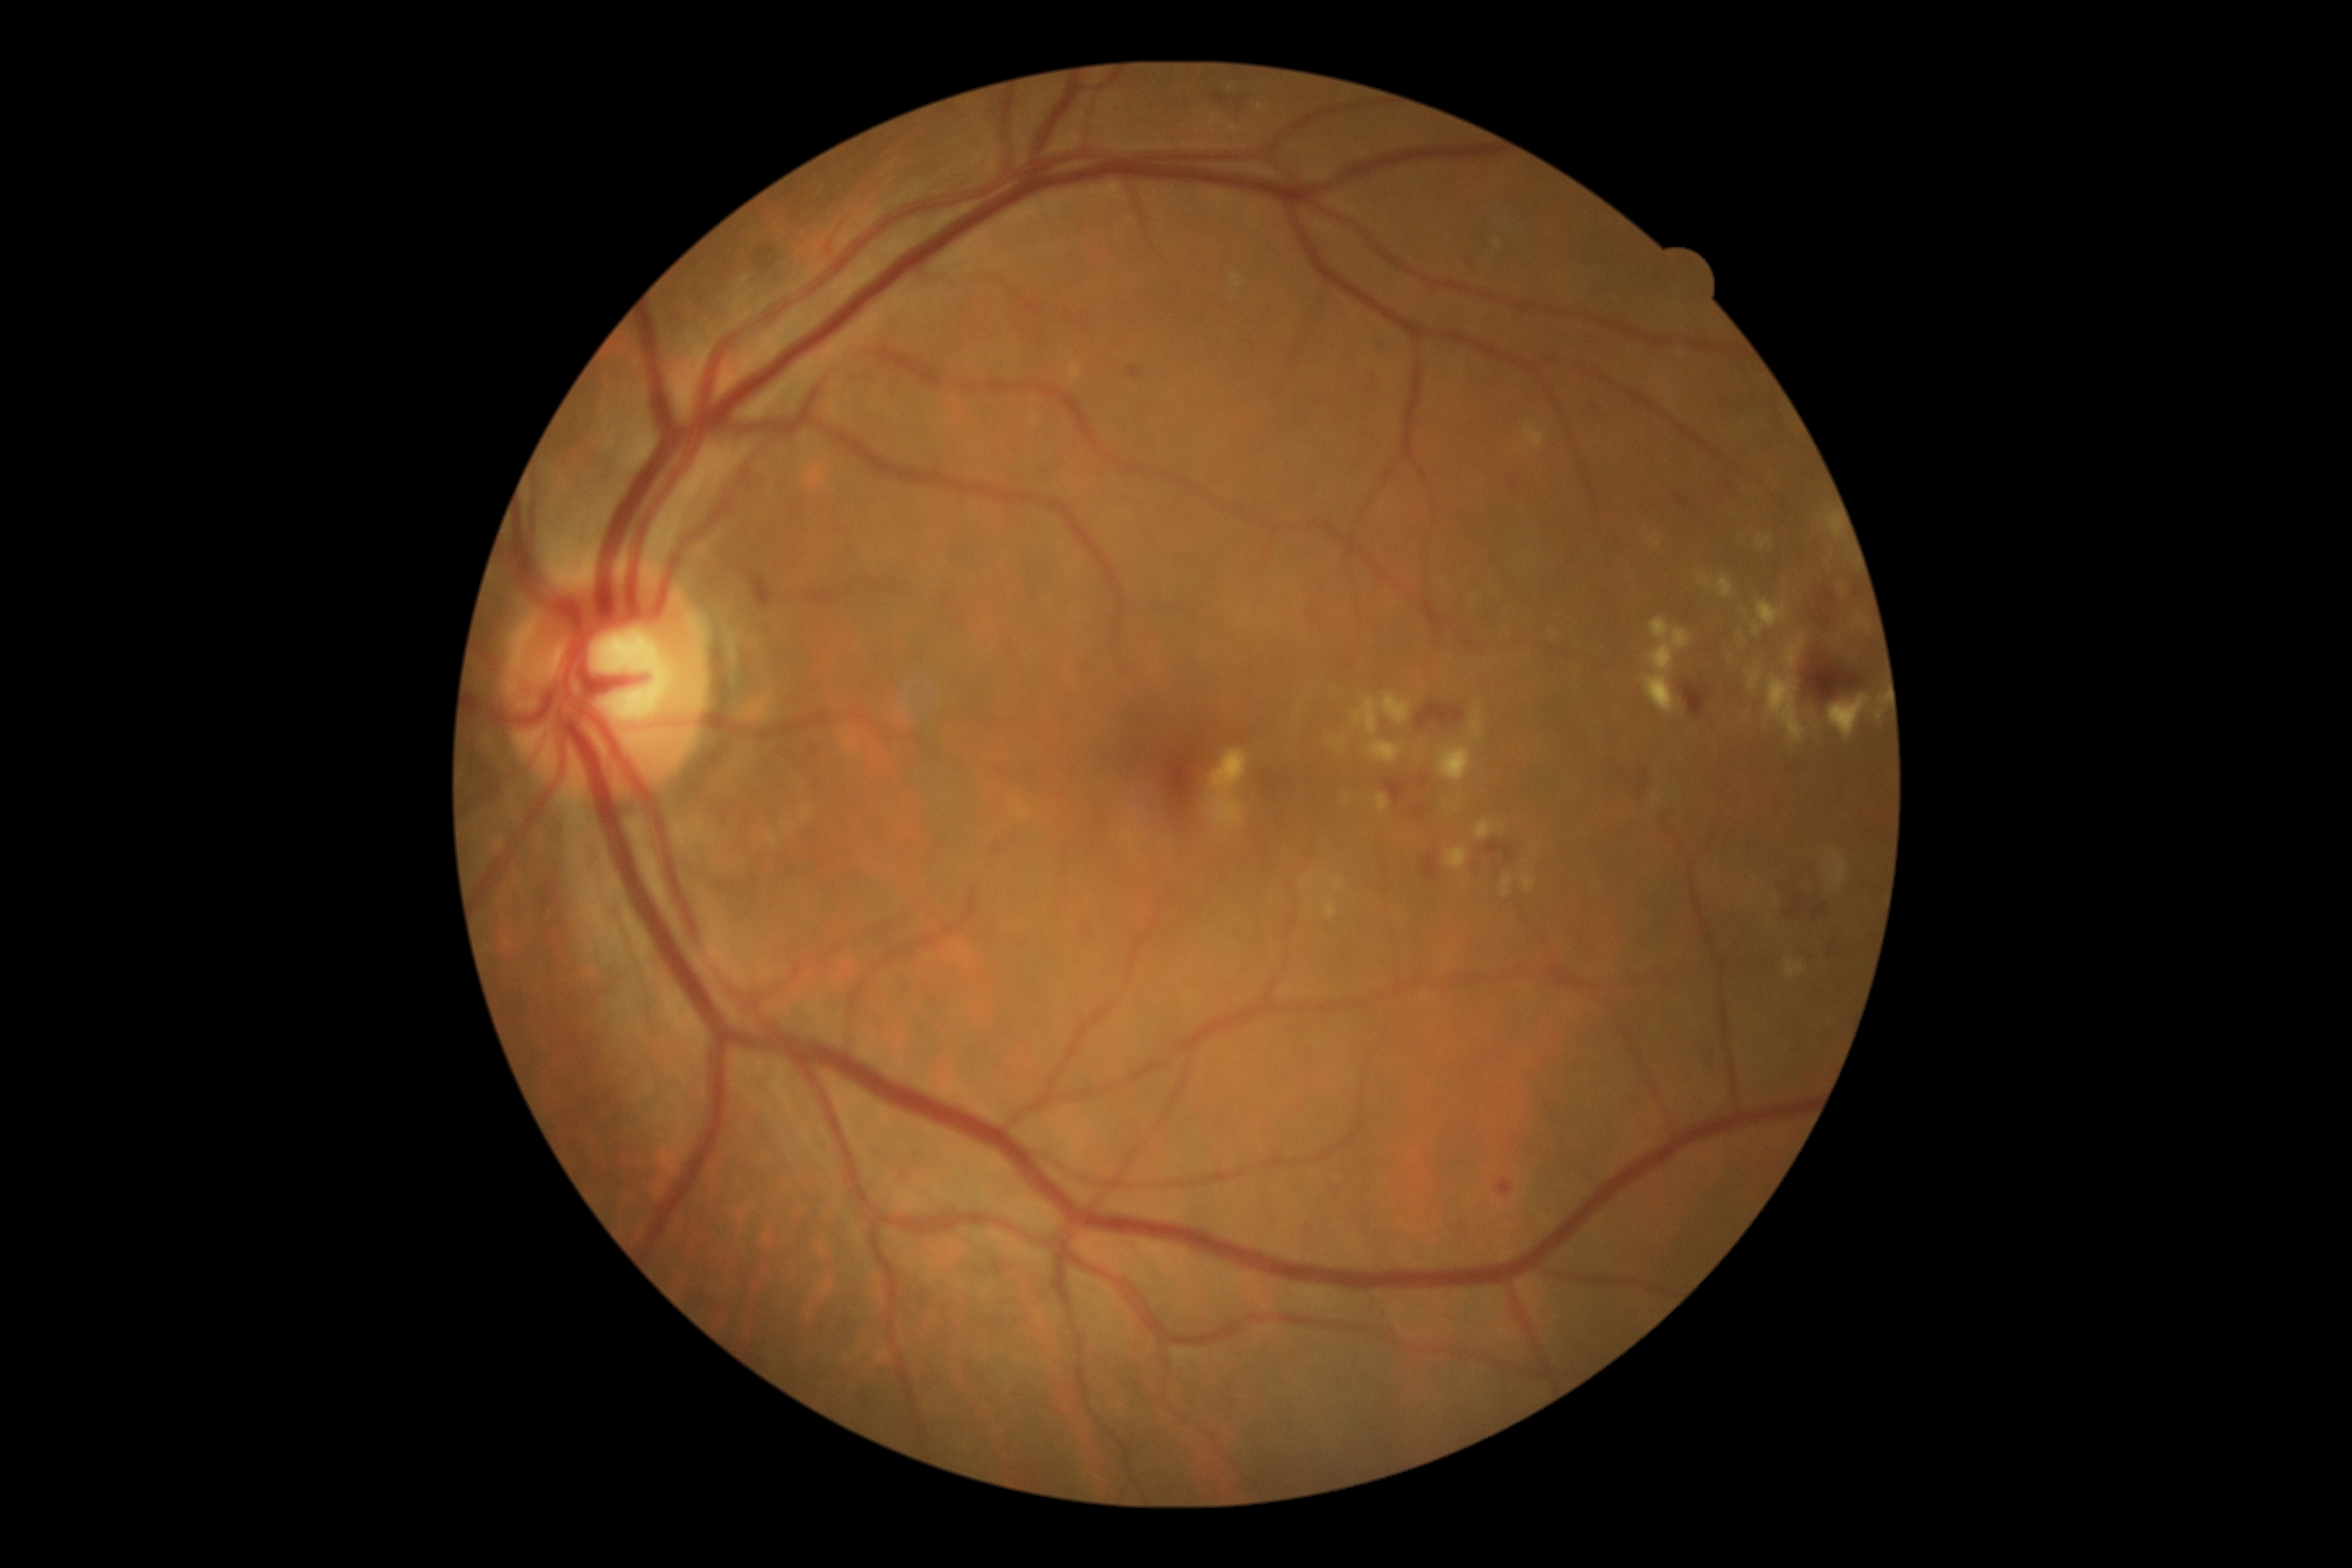 DR is 2.